Pediatric retinal photograph (wide-field) — 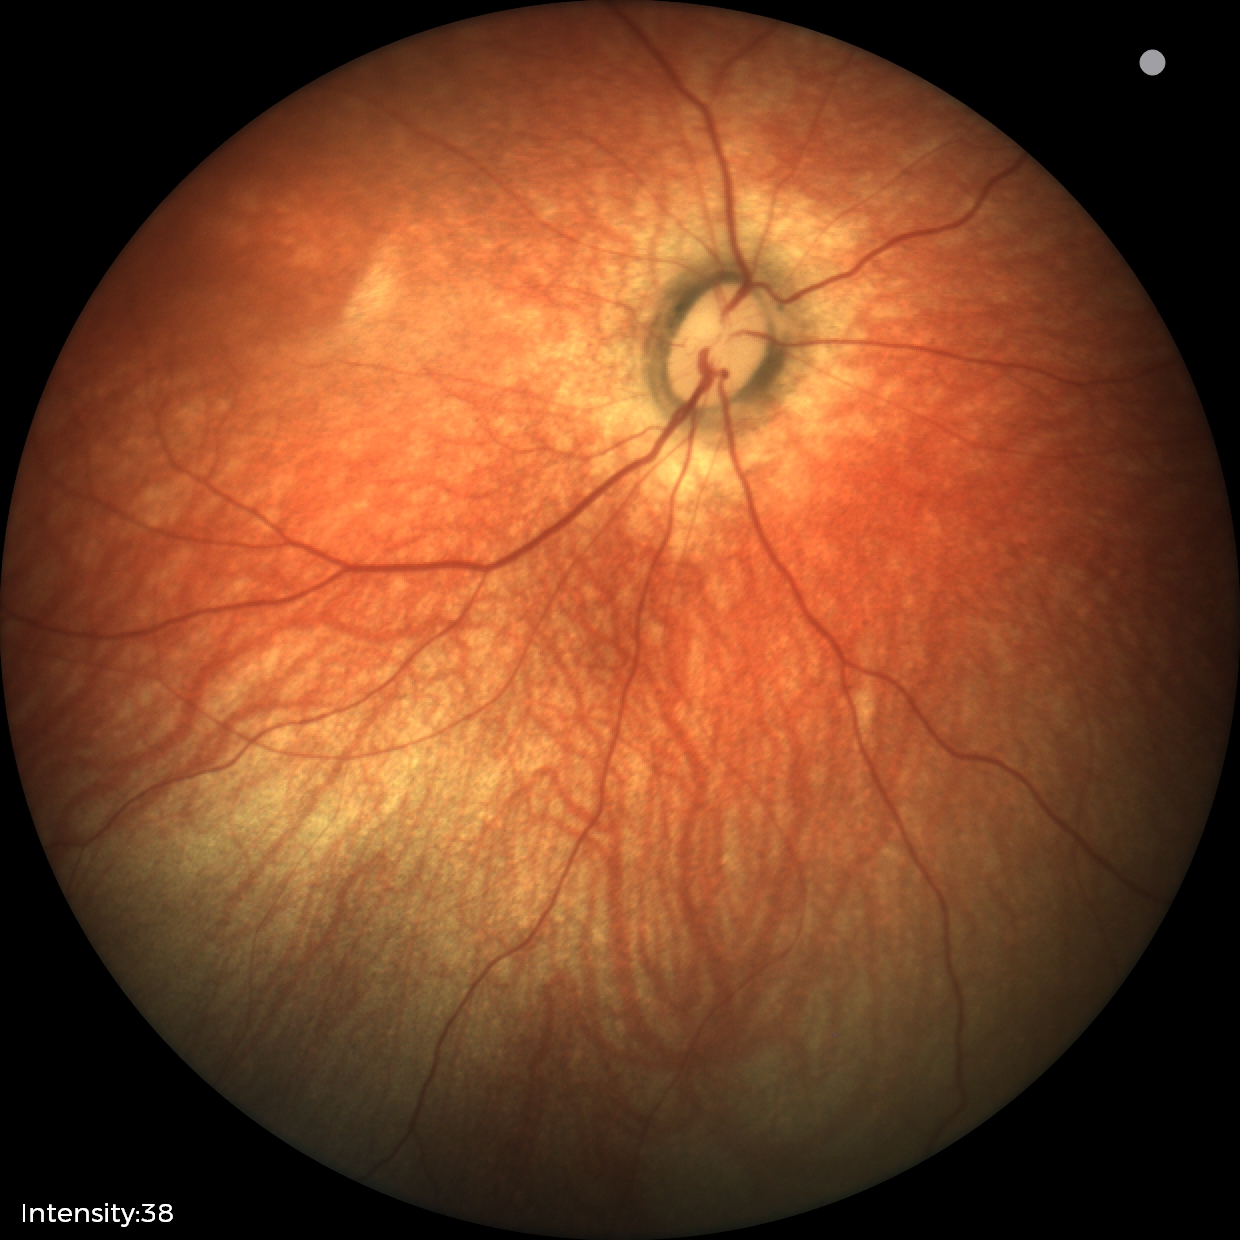 Screening examination diagnosed as physiological.